2228x1652. Field includes the optic disc and macula
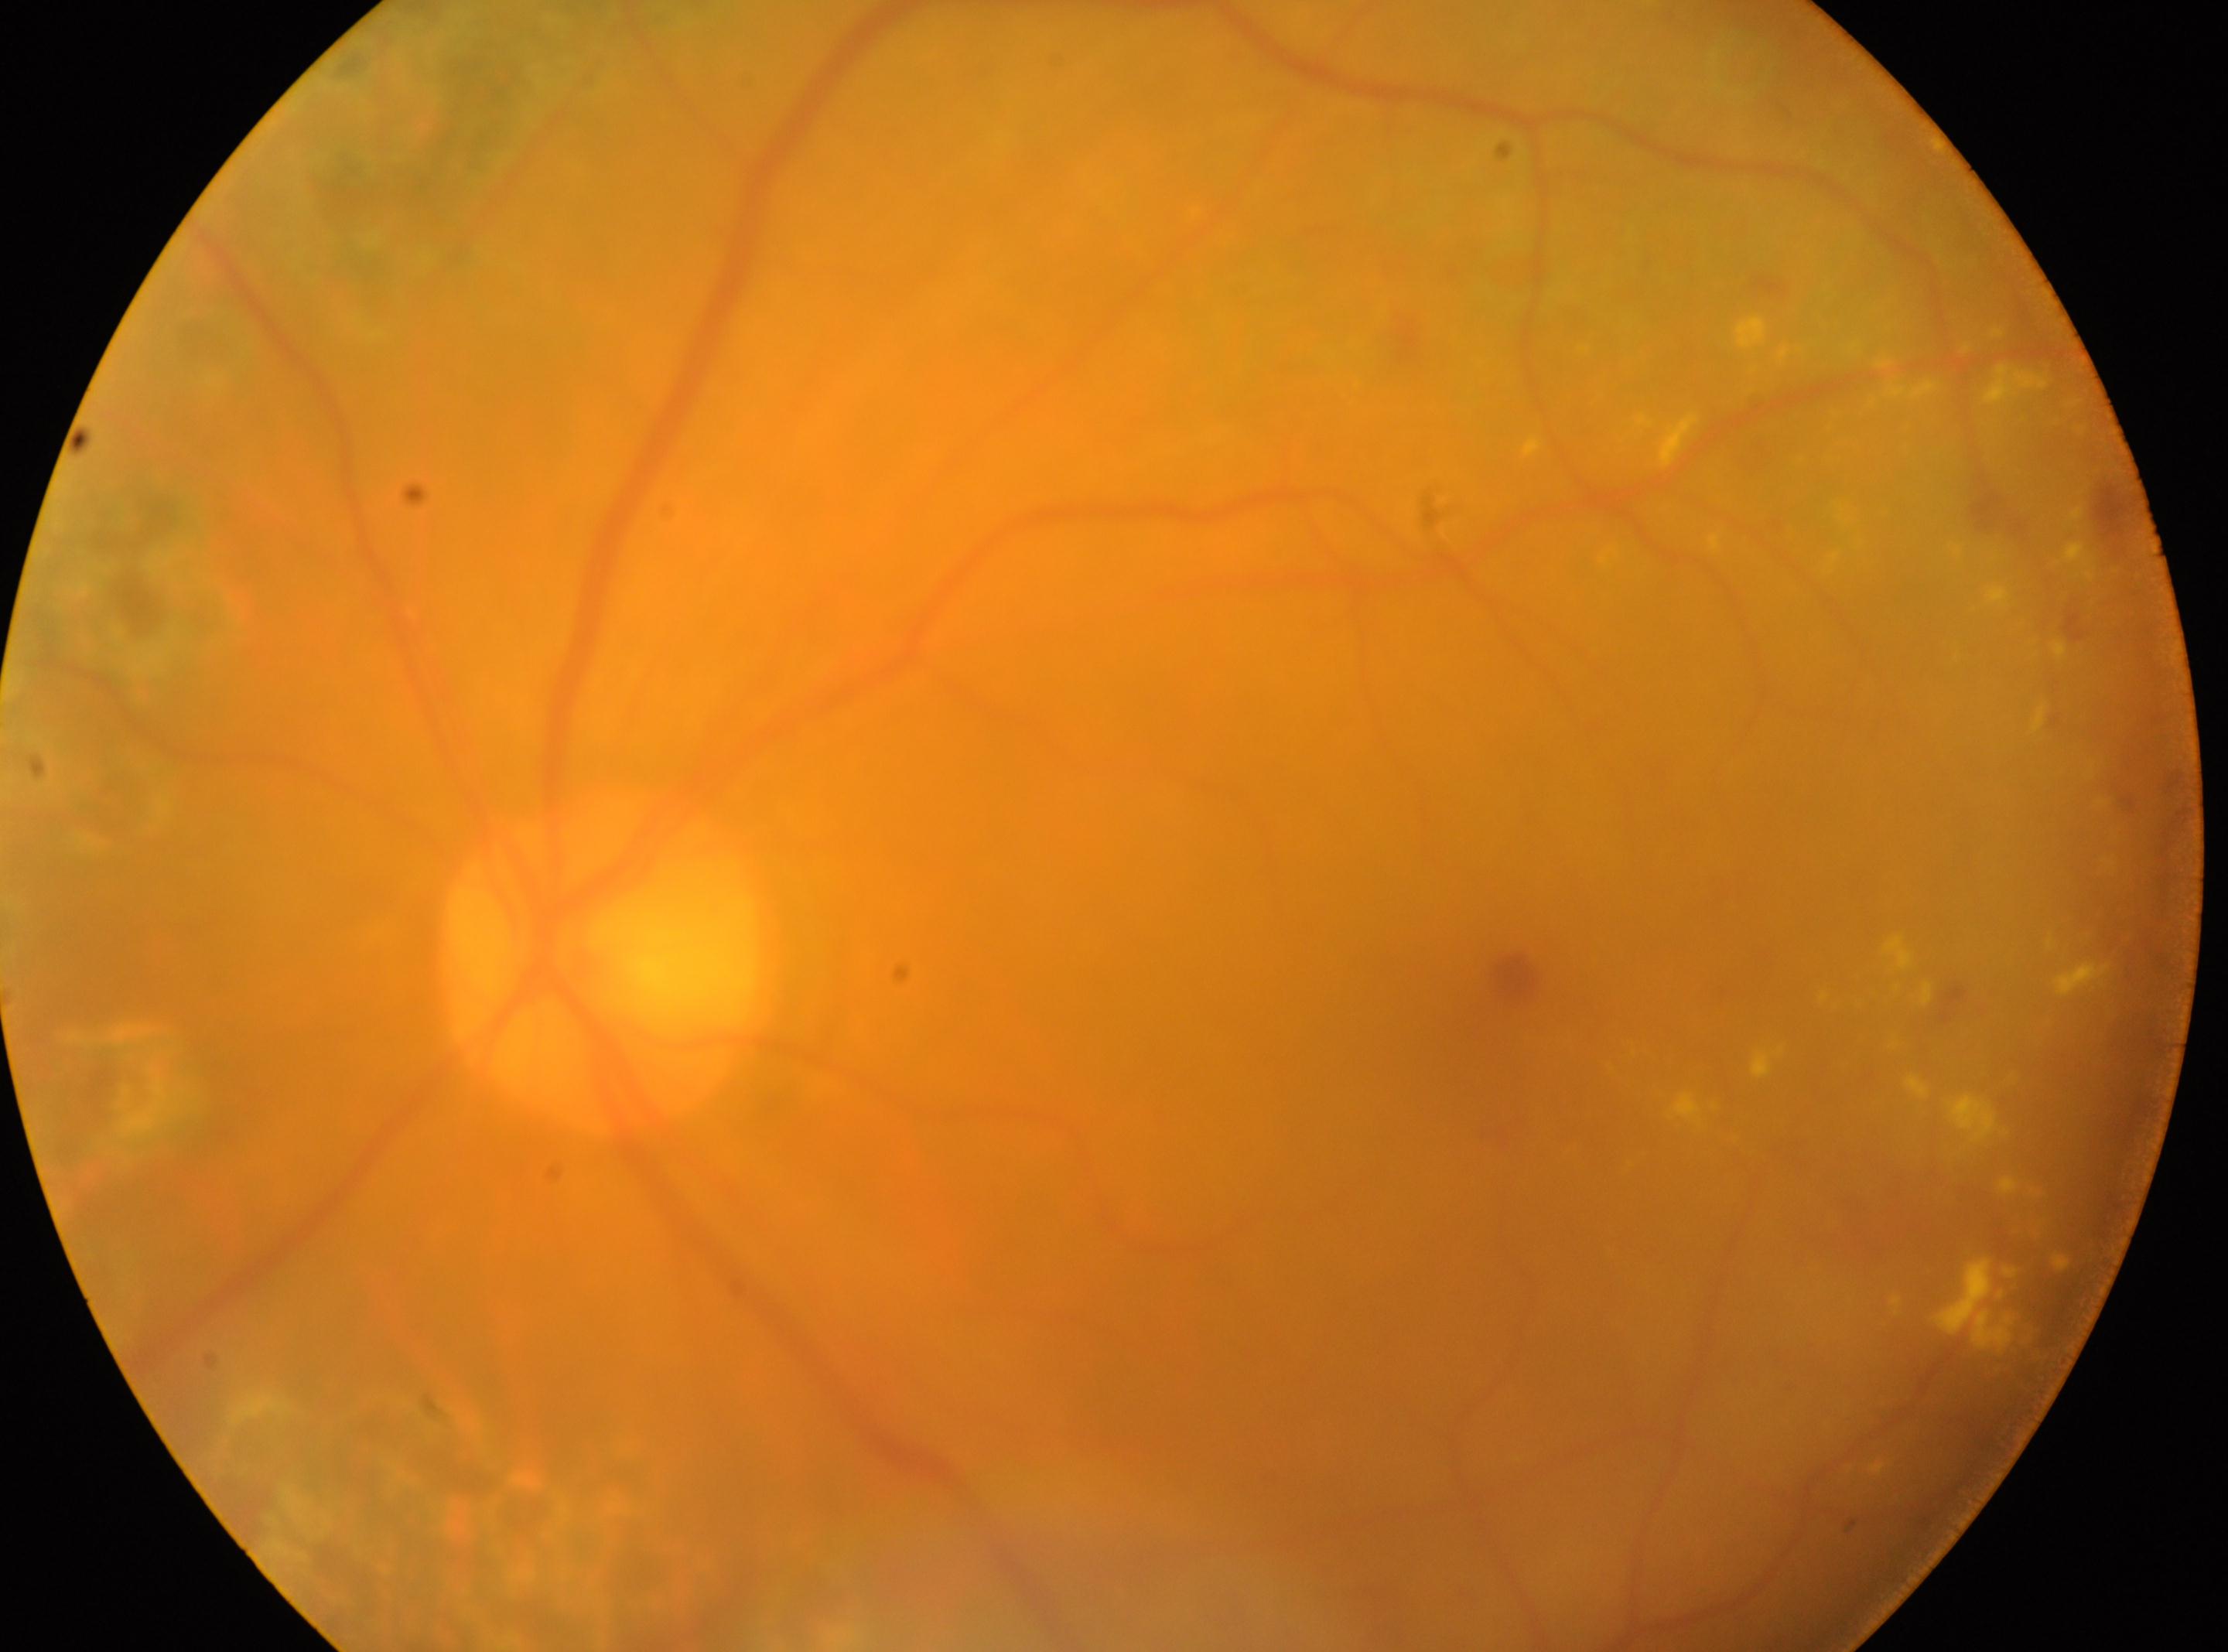

Optic disc located at [604, 966]. Retinopathy grade is post-photocoagulation DR, with underlying moderate NPDR (grade 2). Imaged eye: left eye. The macular center is at [1524, 987].